Without pupil dilation; image size 848x848; FOV: 45 degrees; fundus photo.
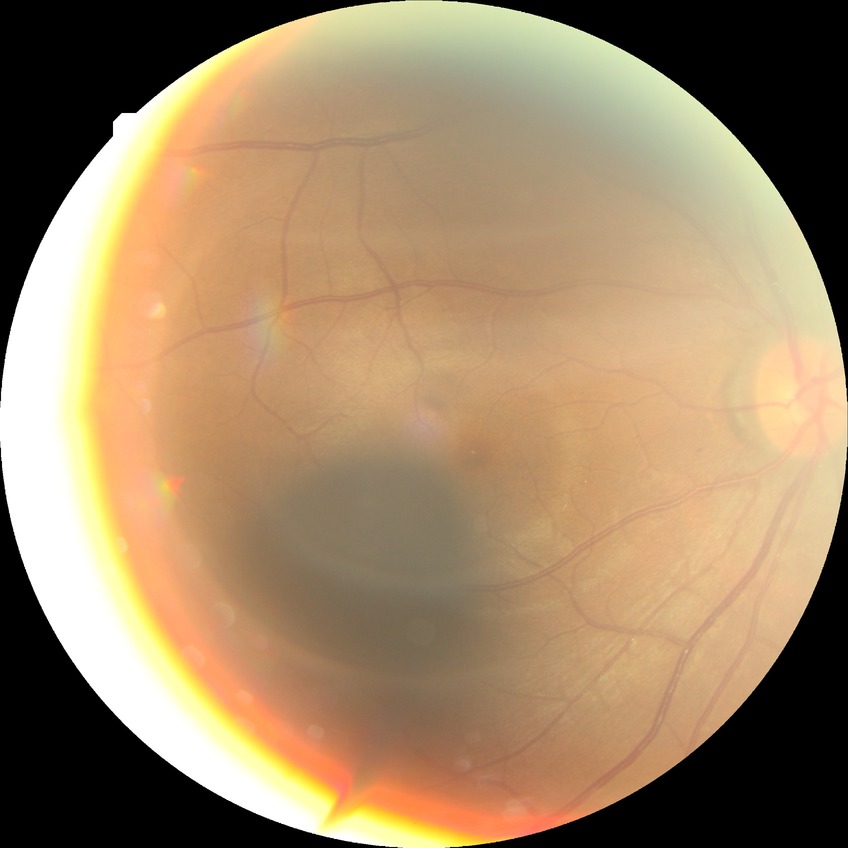 Retinopathy stage is simple diabetic retinopathy.
The retinopathy is classified as non-proliferative diabetic retinopathy.